Acquired on the Phoenix ICON · wide-field fundus photograph of an infant:
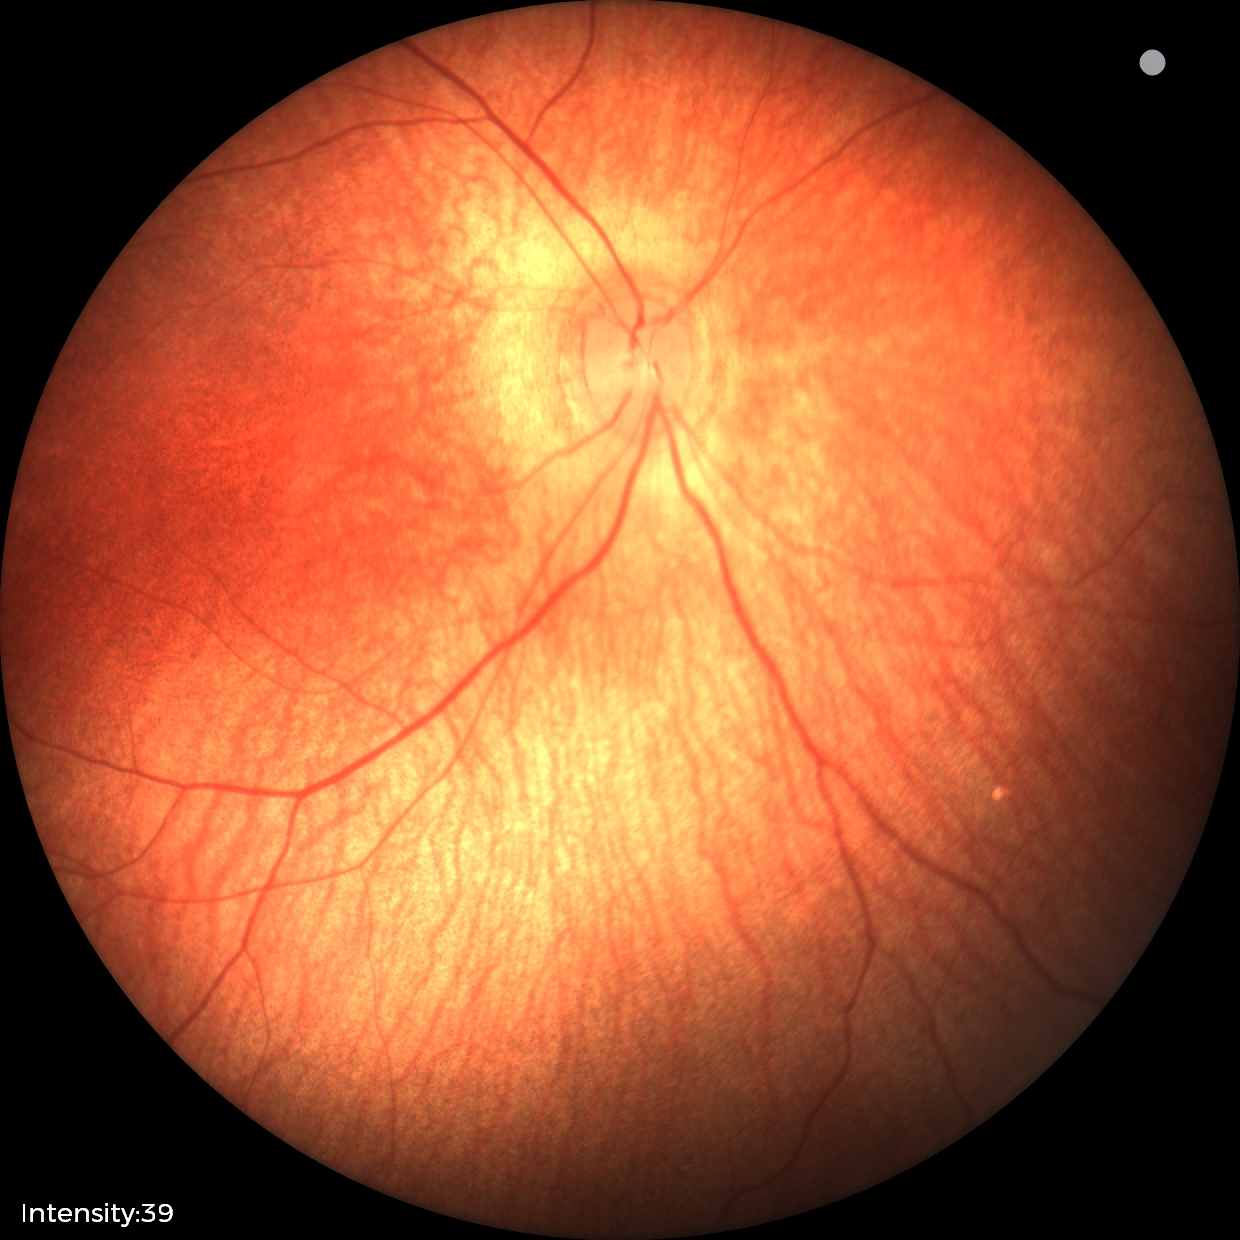
Screening examination diagnosed as physiological.